2212 by 1659 pixels:
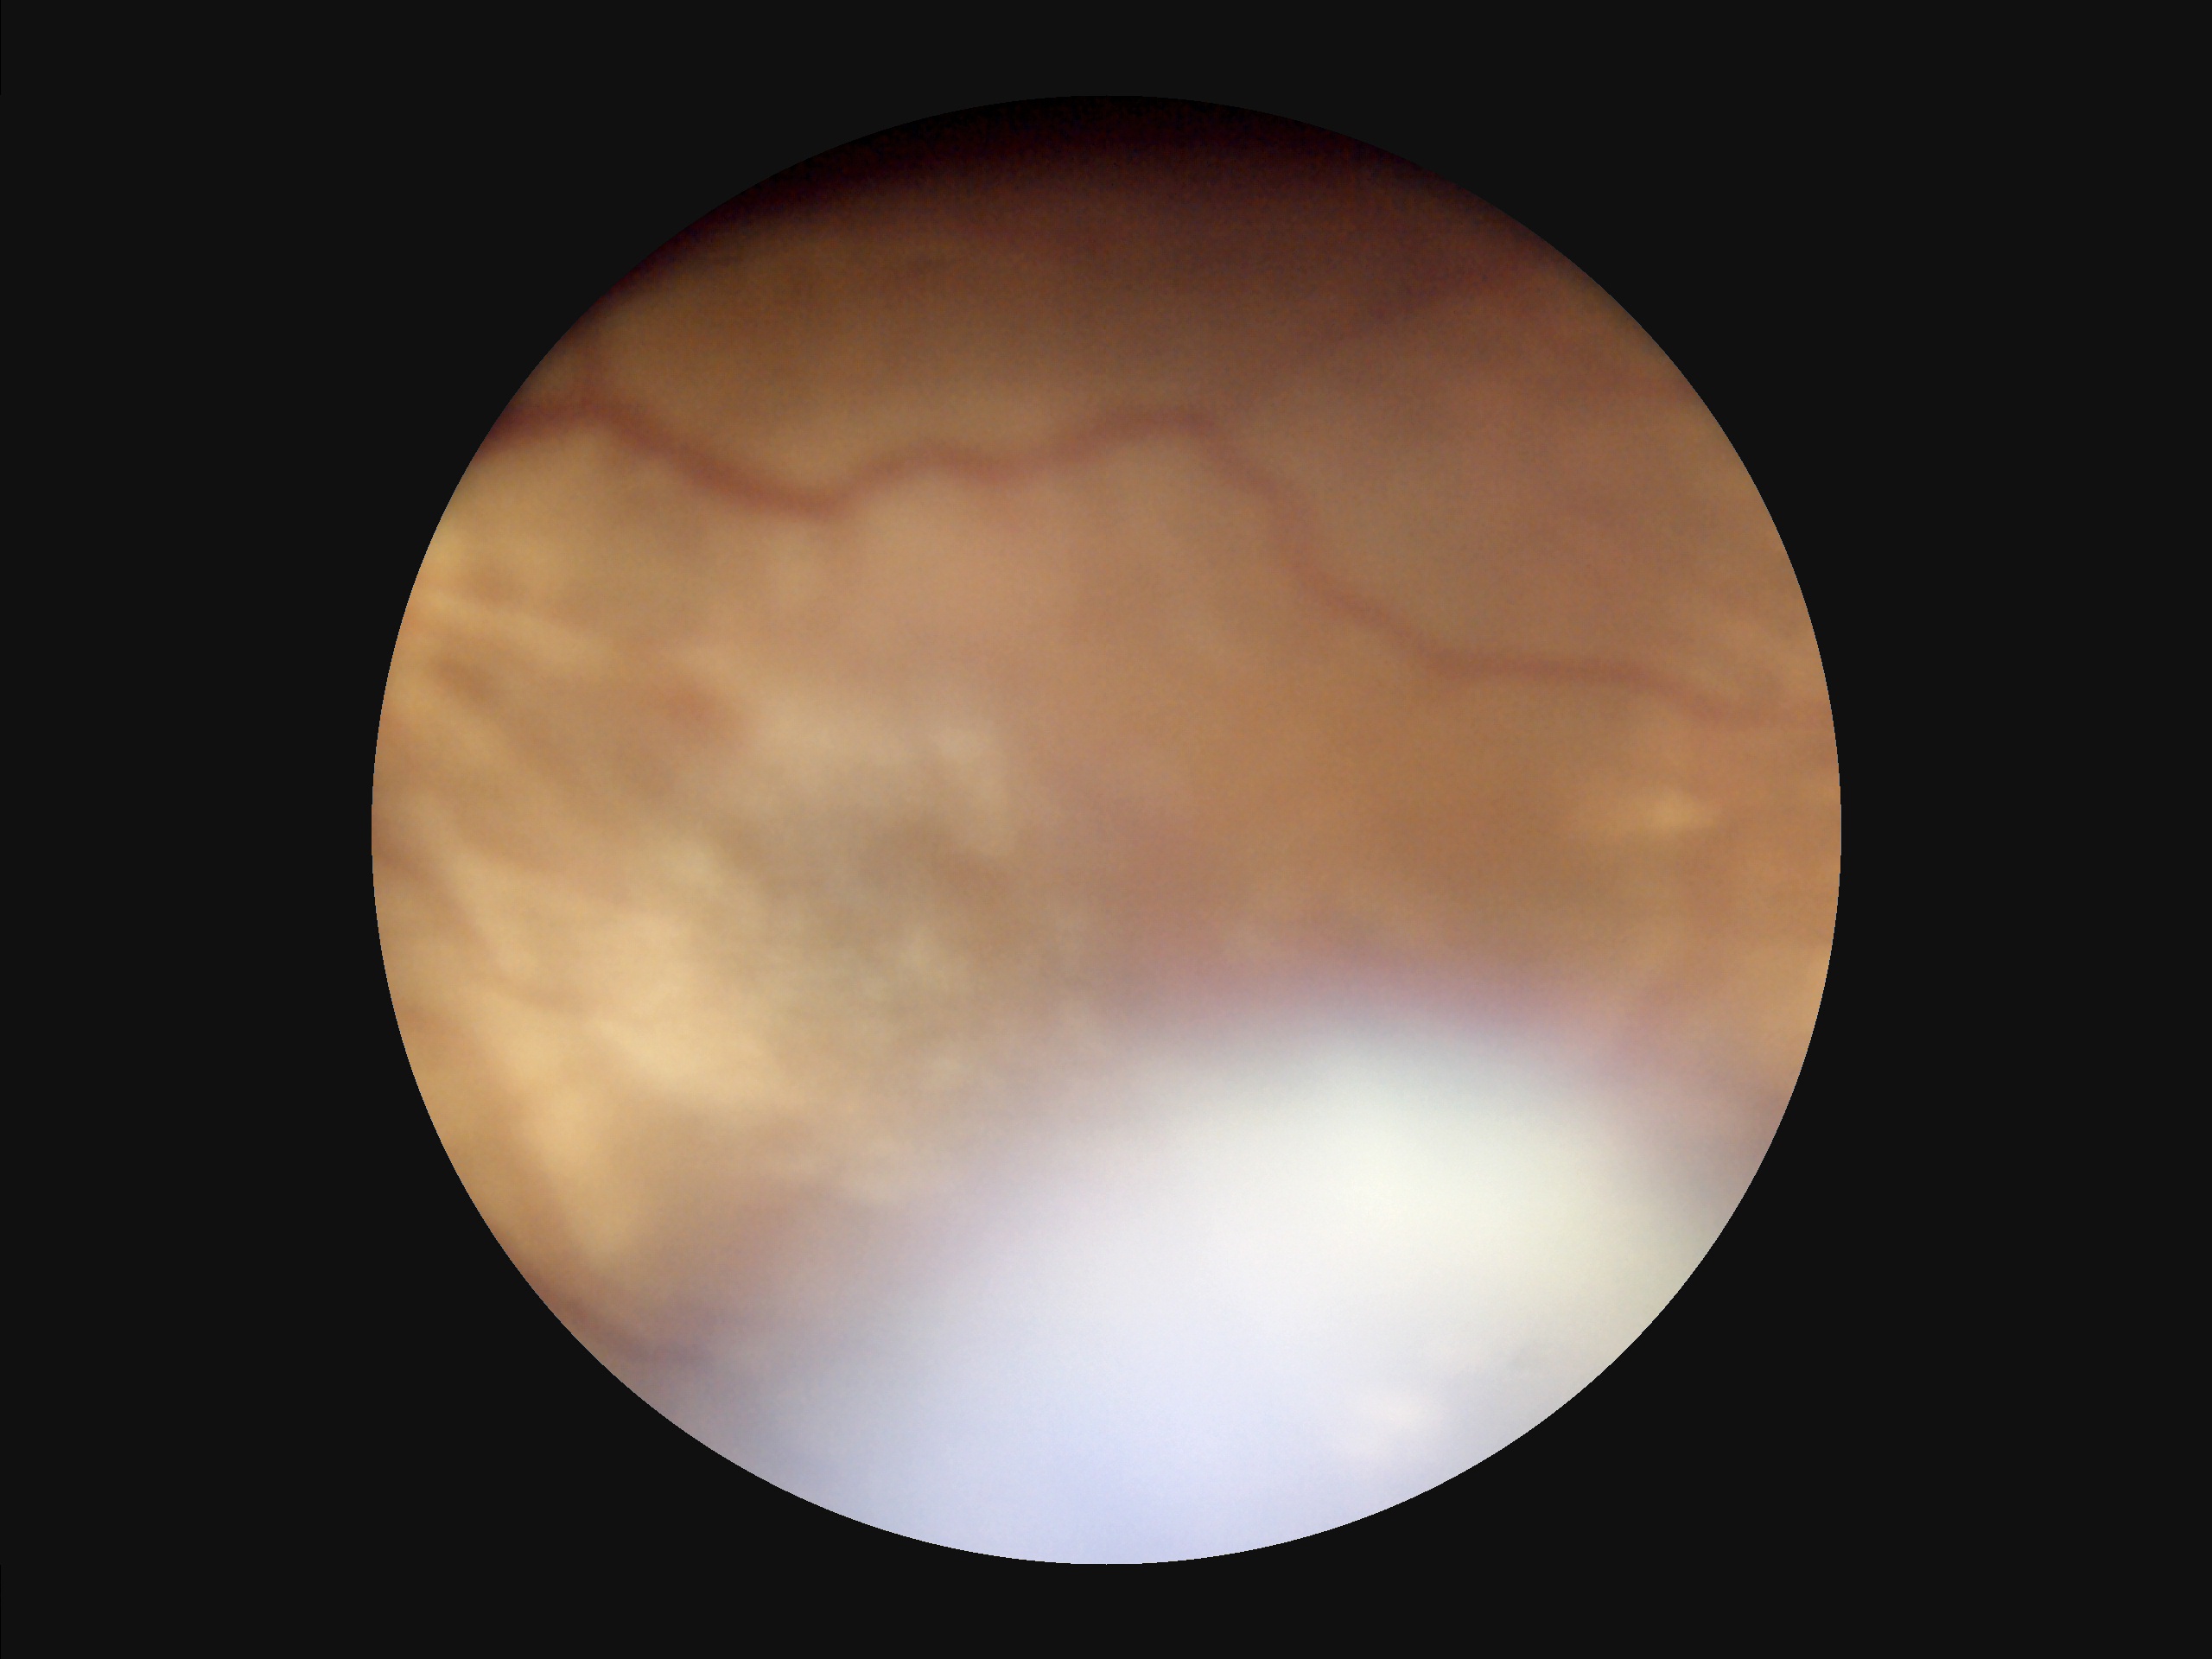

contrast: low
clarity: reduced
illumination: suboptimal
overall_quality: poor